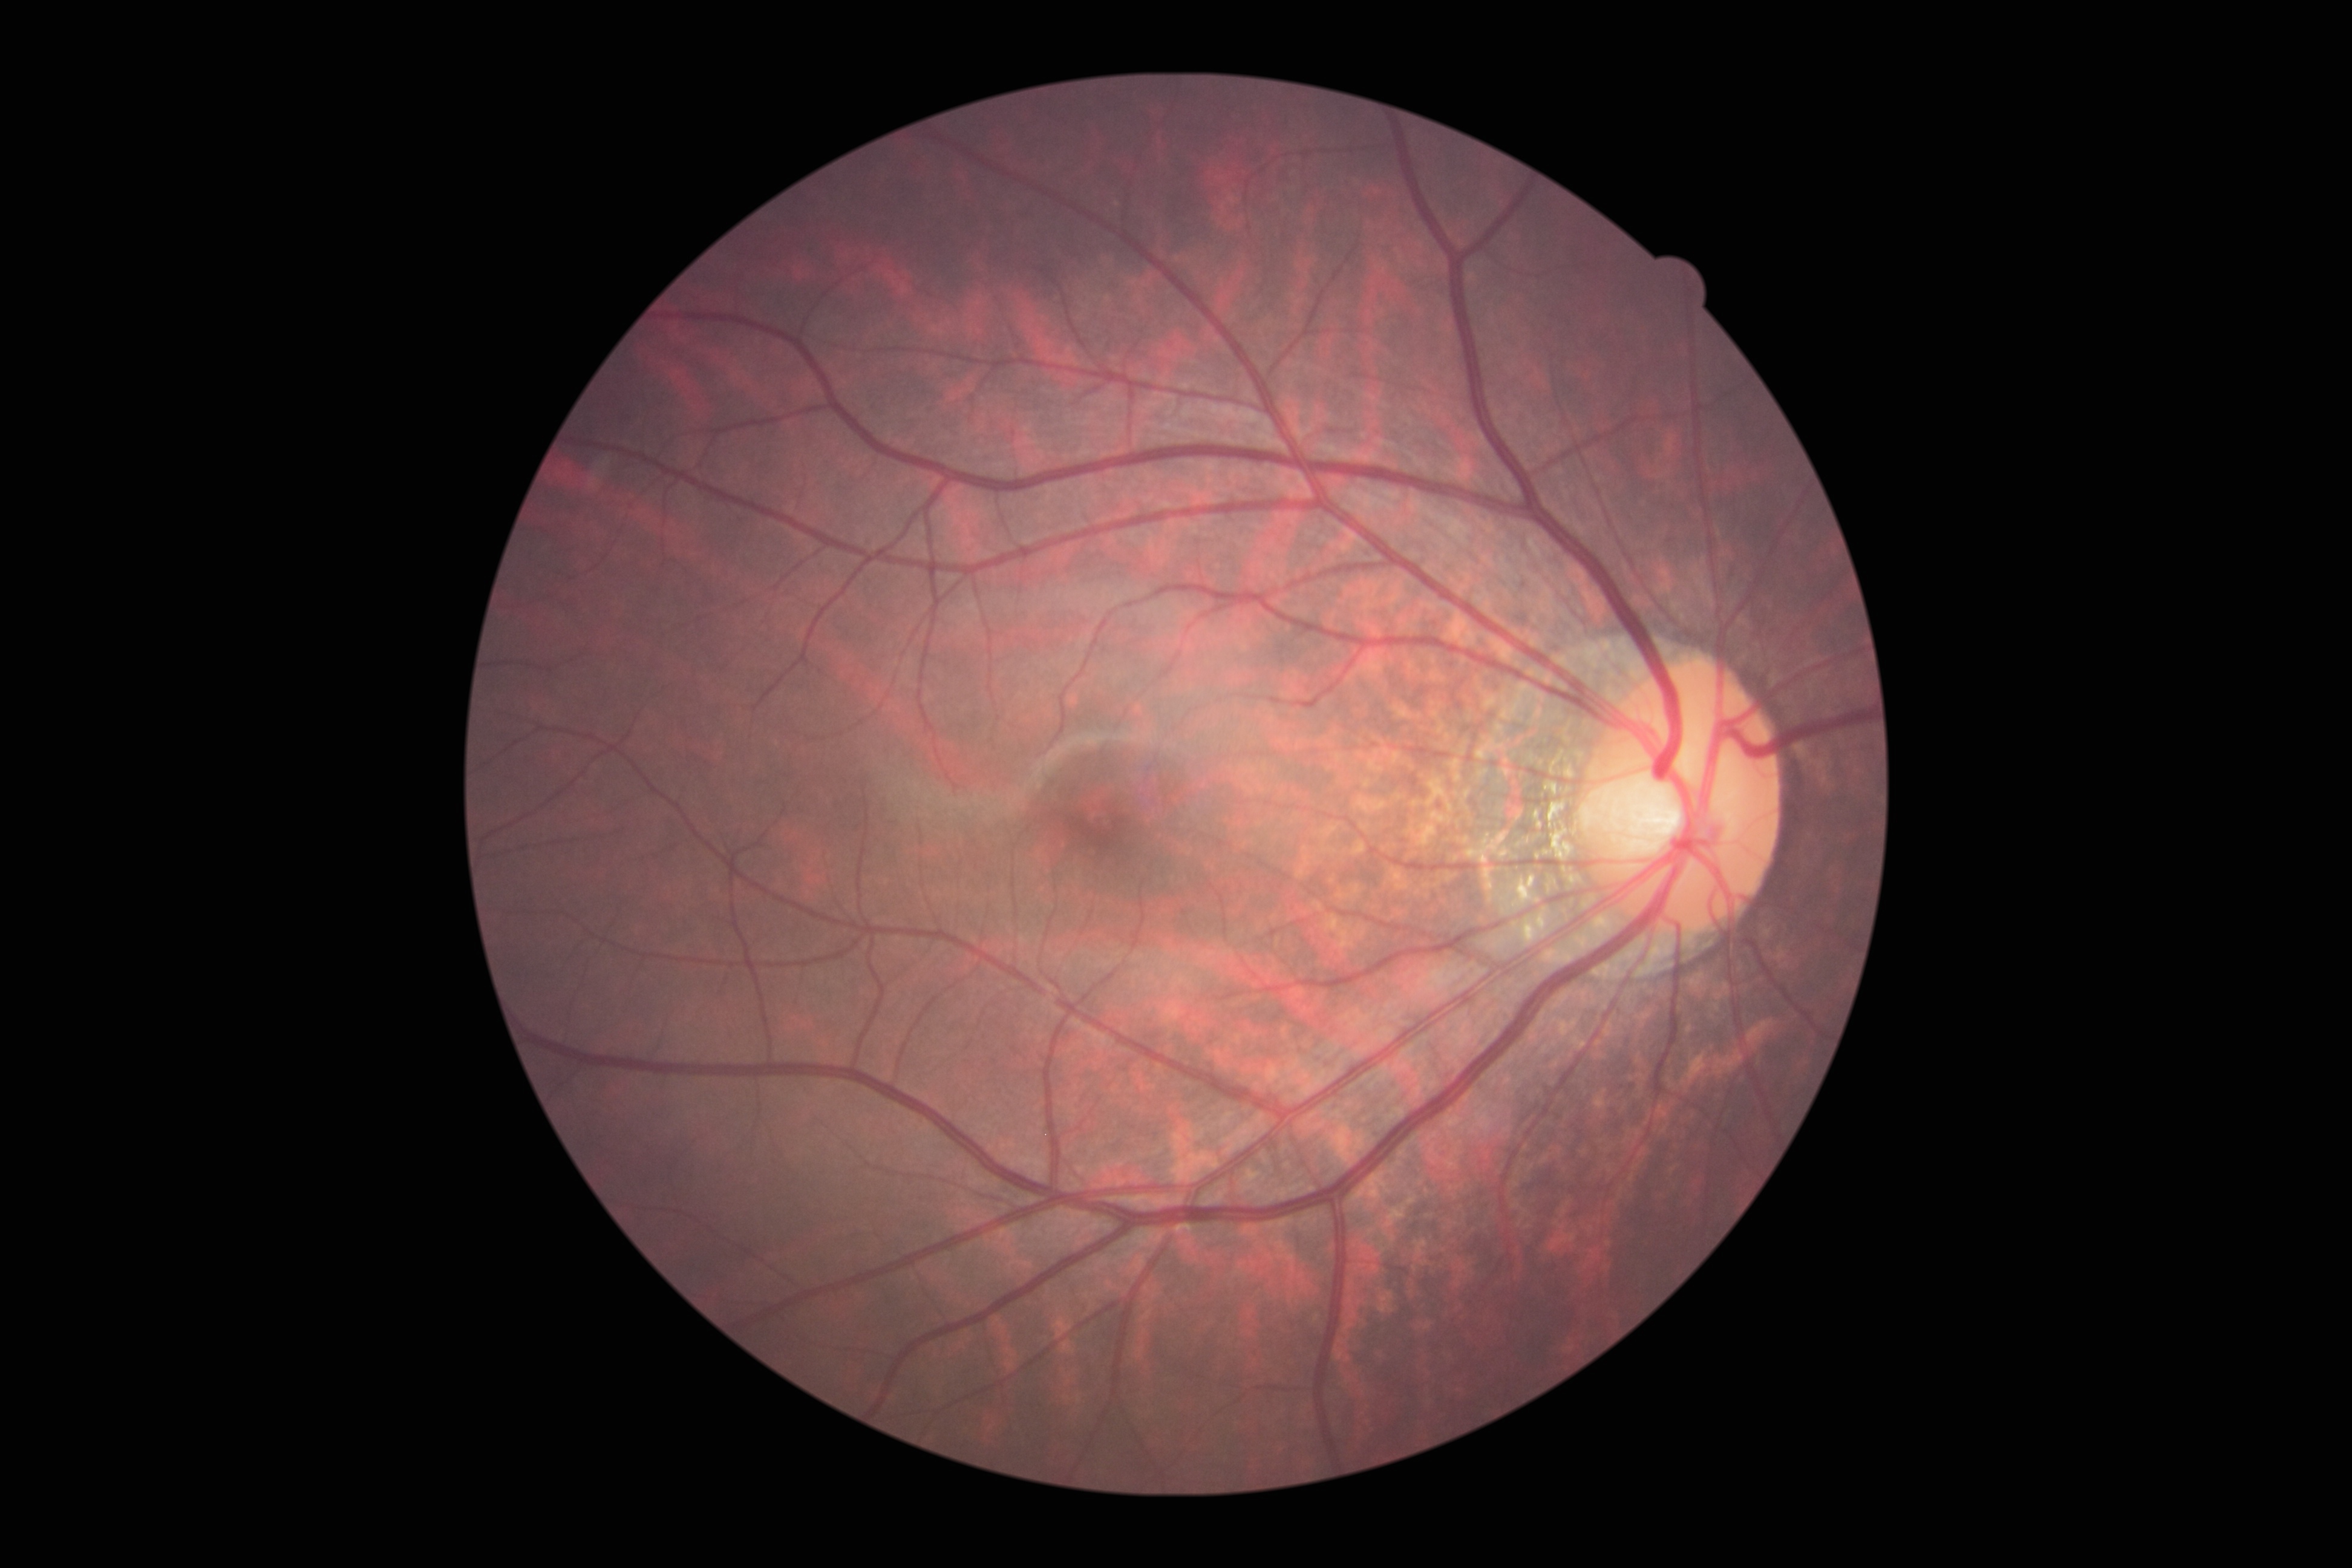
Findings:
• diabetic retinopathy — grade 0 (no apparent retinopathy) — no visible signs of diabetic retinopathy